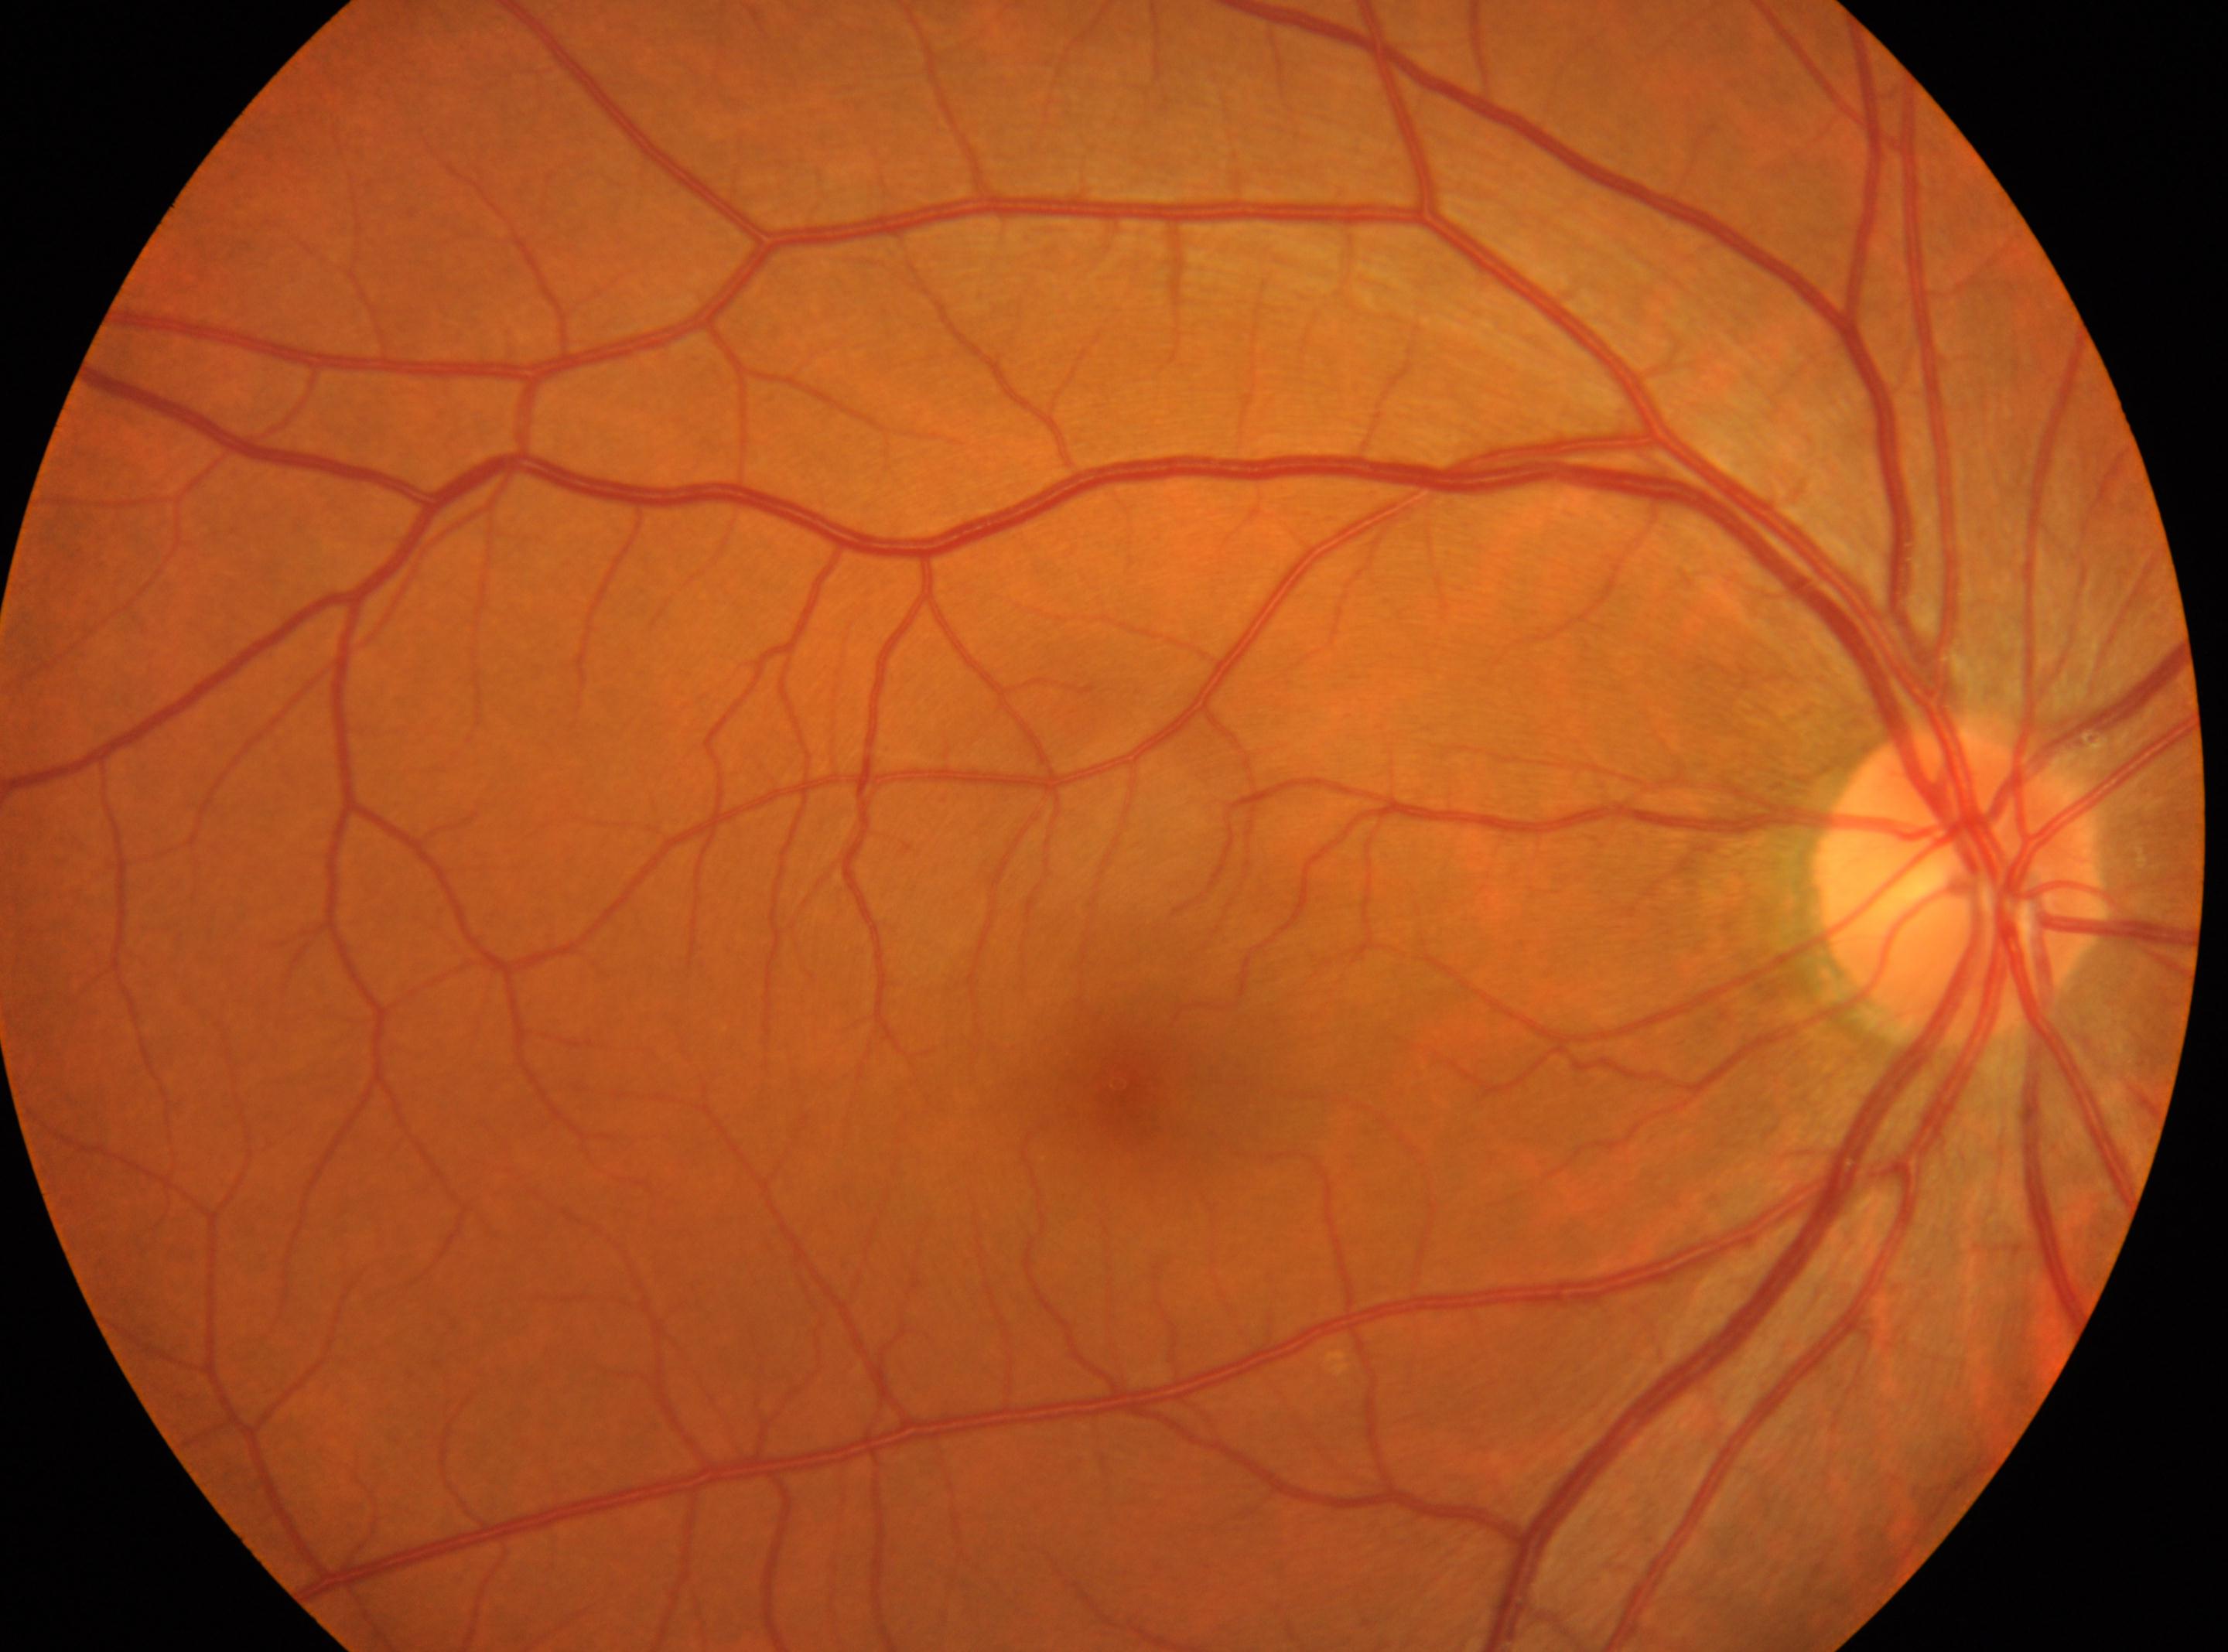

The macular center is at (1119,1083).
The optic disc is at (1960,875).
Imaged eye: right eye.
DR is 0/4.